45° field of view, 848x848px — 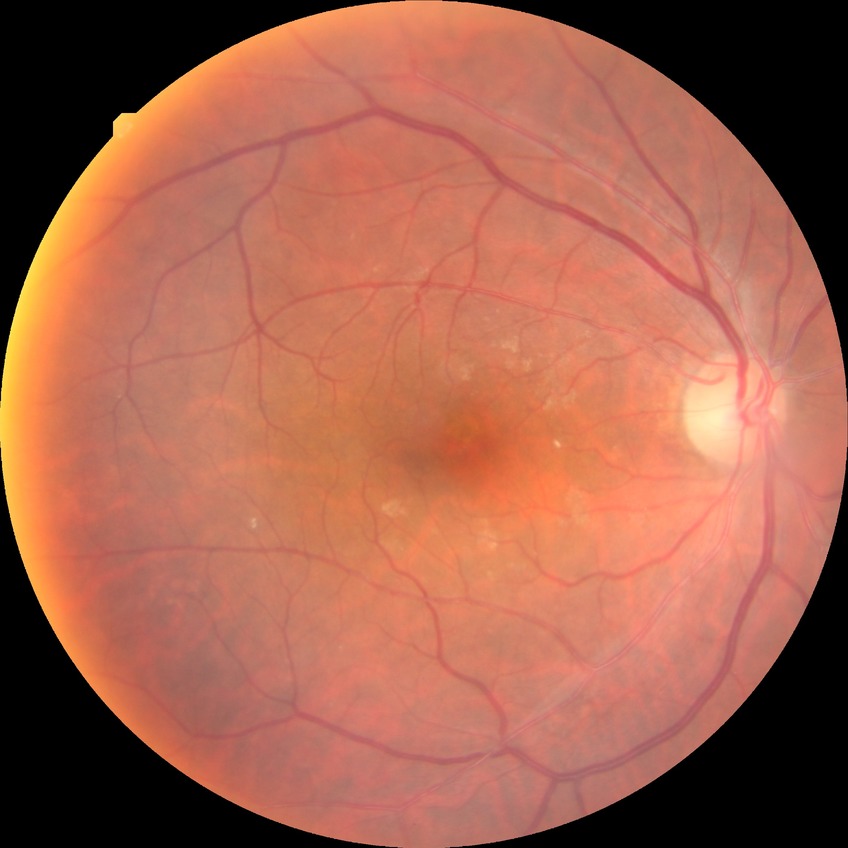

diabetic retinopathy (DR): no diabetic retinopathy (NDR).